Modified Davis classification · color fundus image.
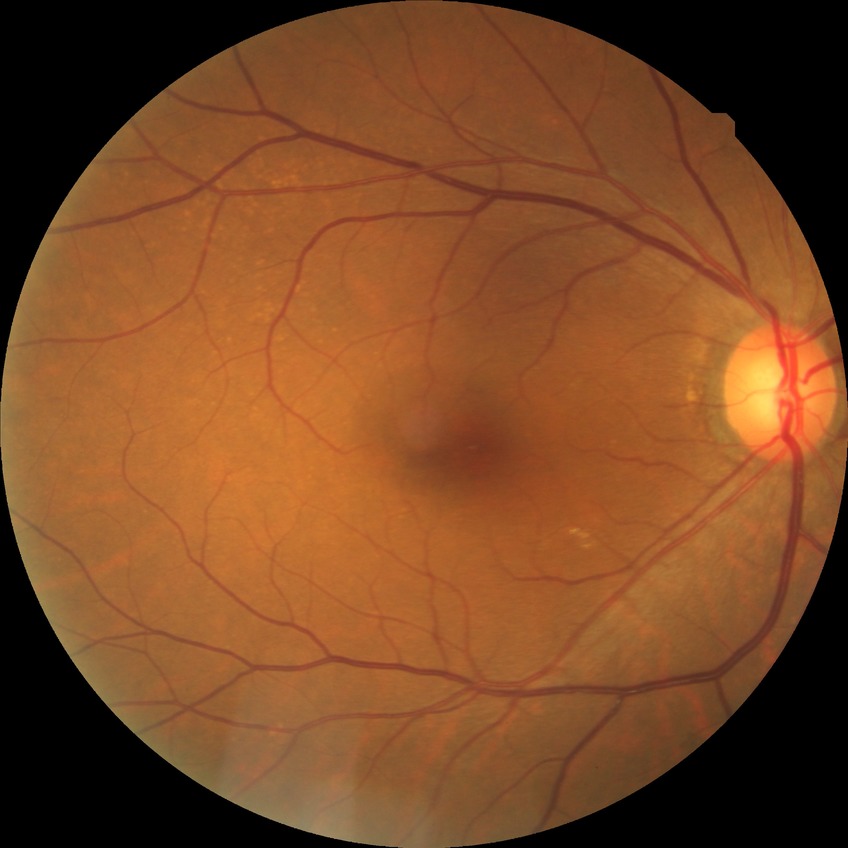

DR stage is NDR.